Nonmydriatic fundus photograph, 45° FOV, modified Davis classification — 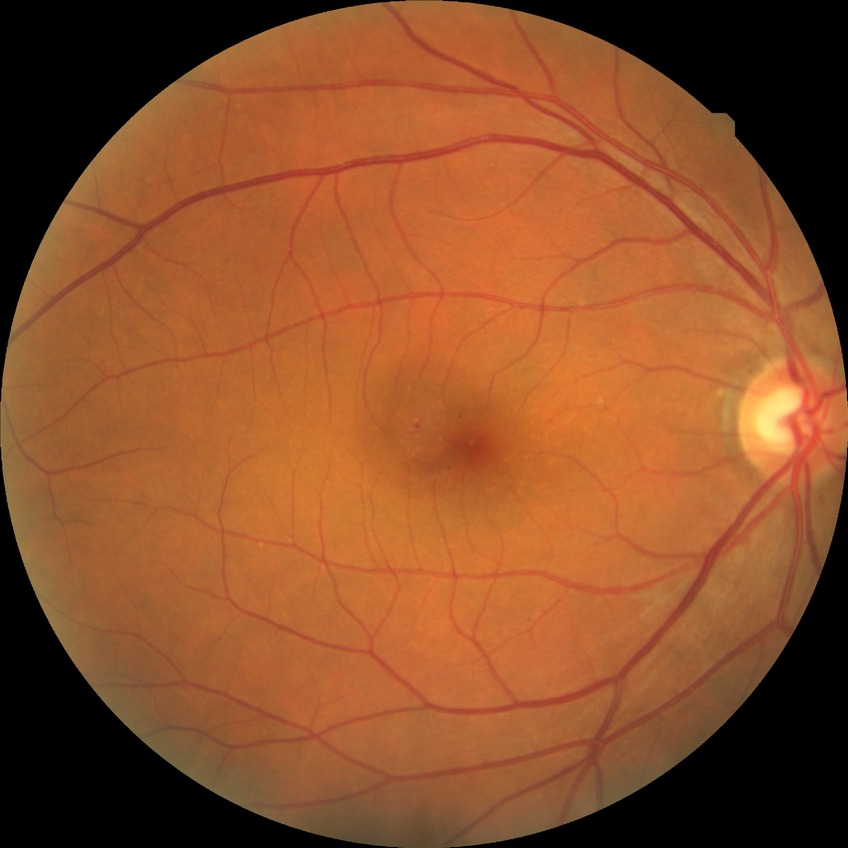

Diabetic retinopathy (DR) is simple diabetic retinopathy (SDR).